45° FOV; CFP; 2212 x 1659 pixels
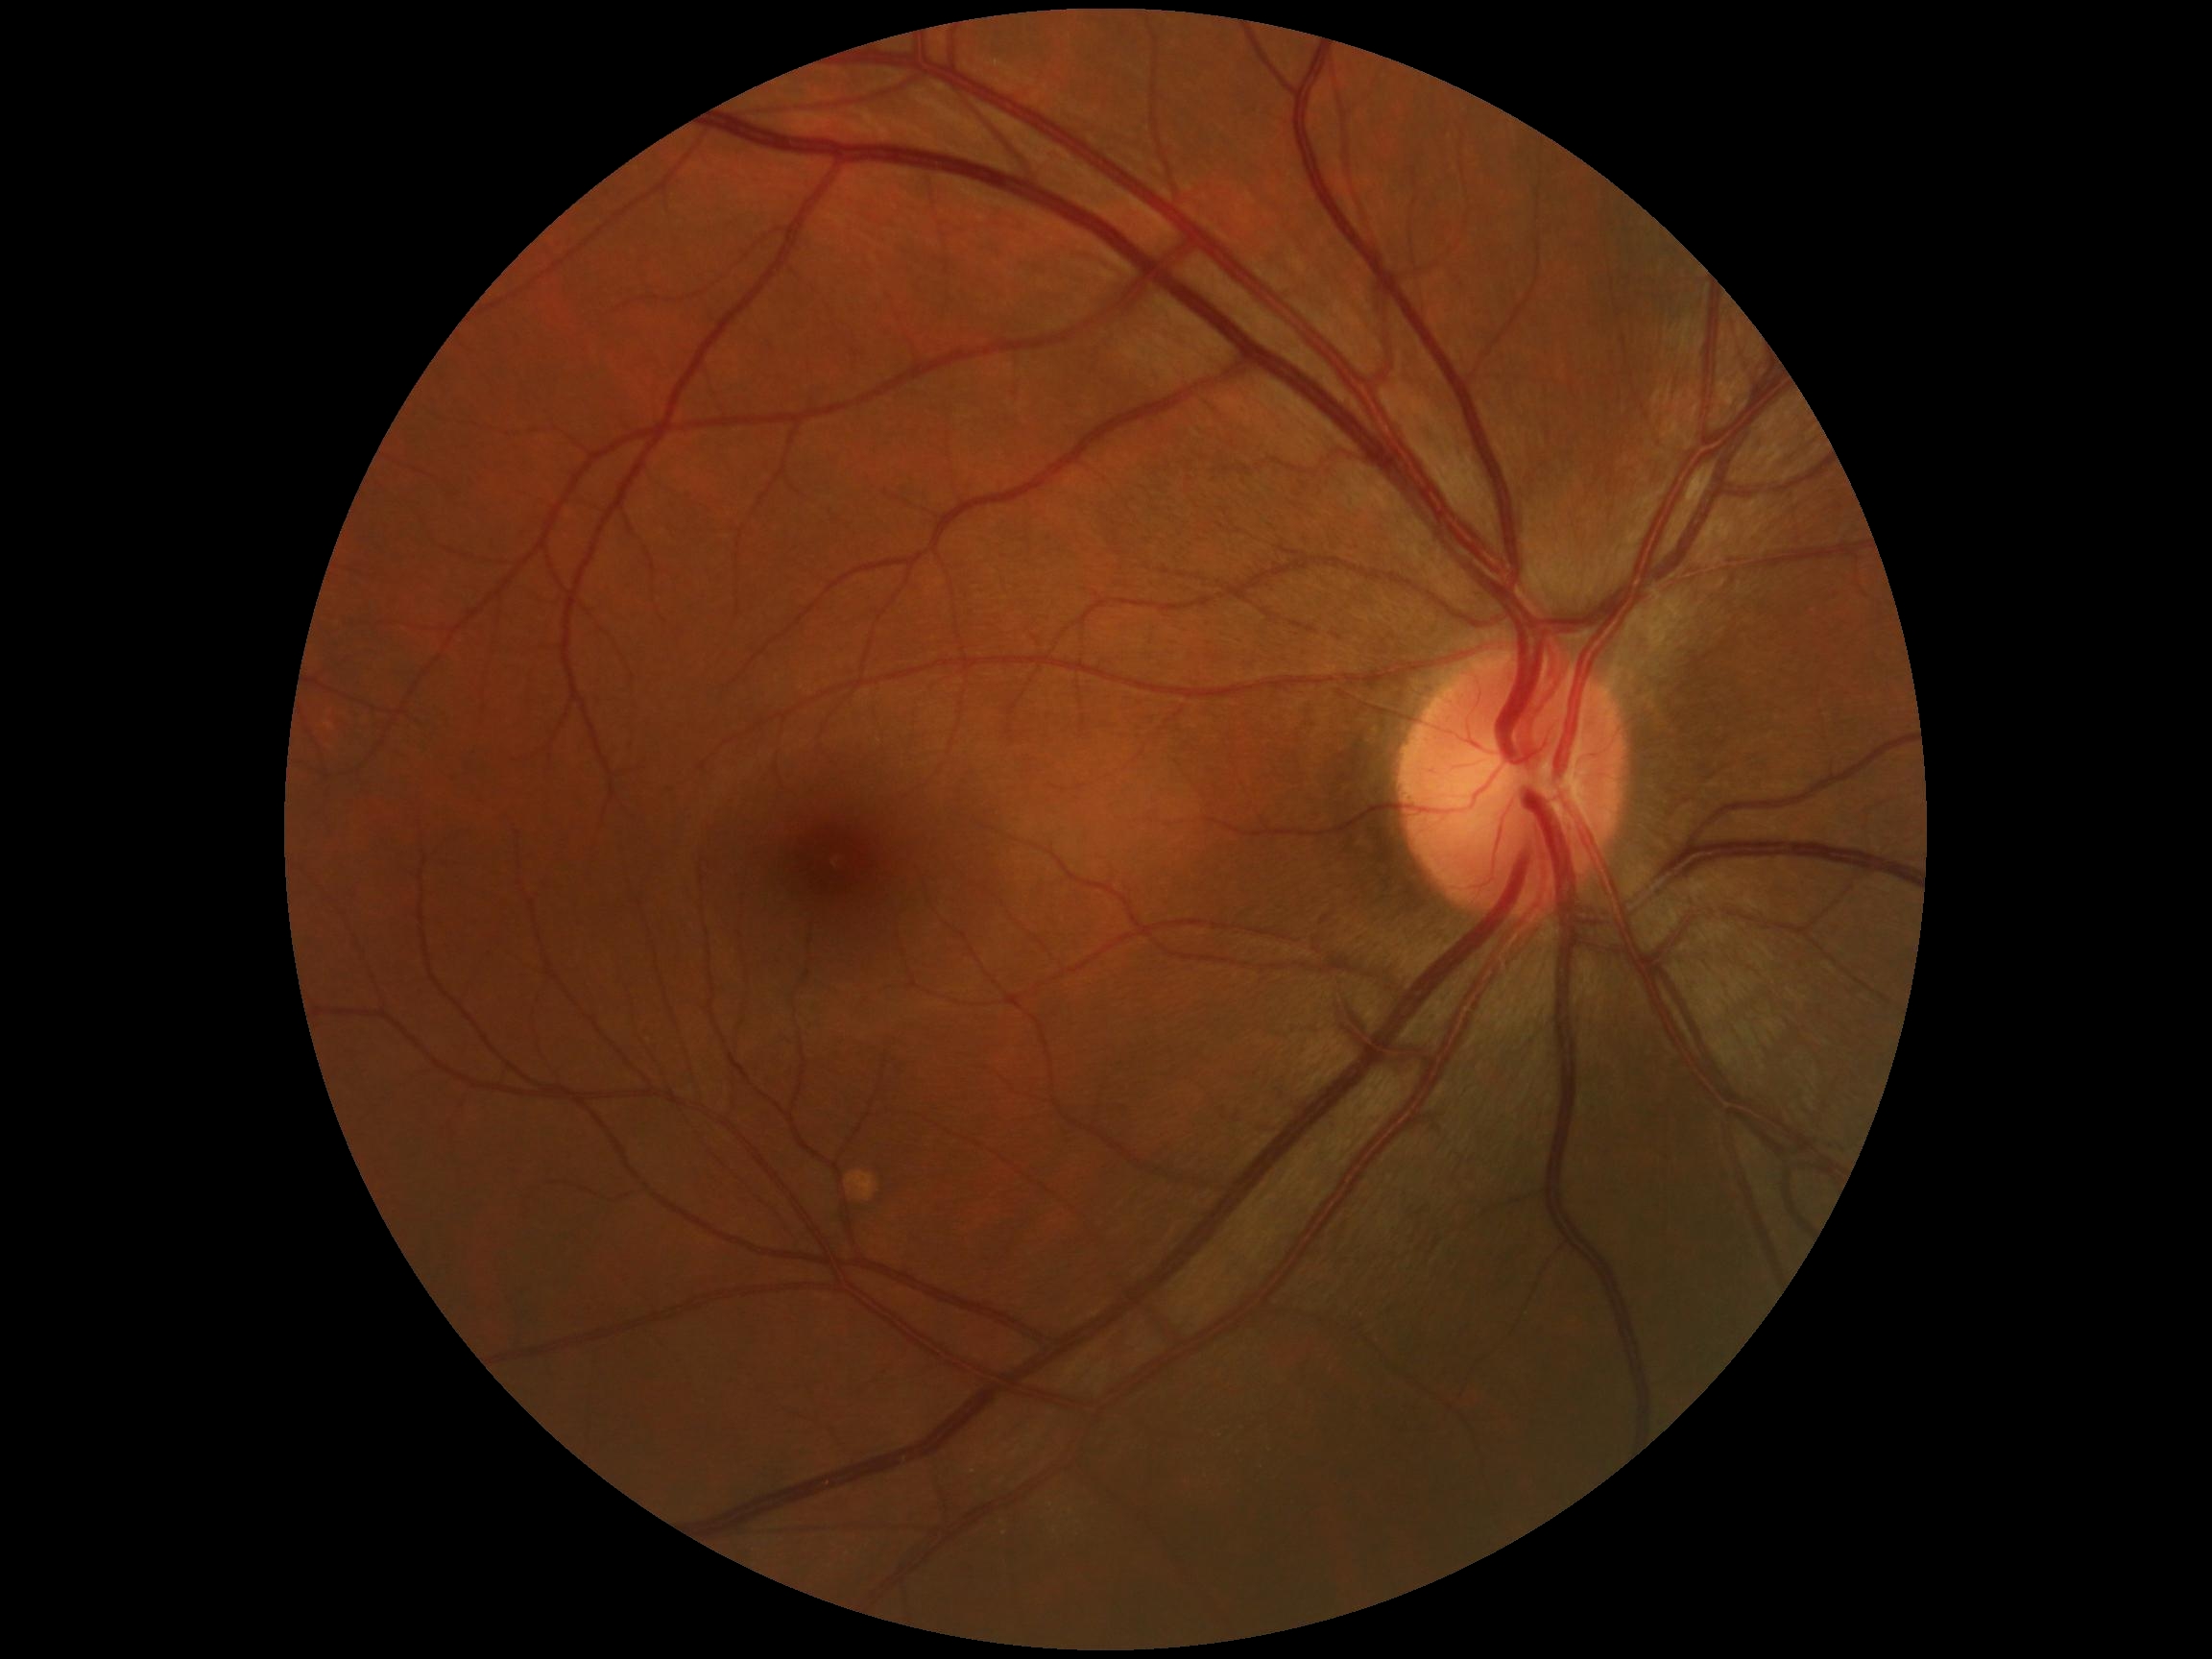

diabetic retinopathy (DR): grade 0 (no apparent retinopathy) — no visible signs of diabetic retinopathy | DR impression: no signs of DR.